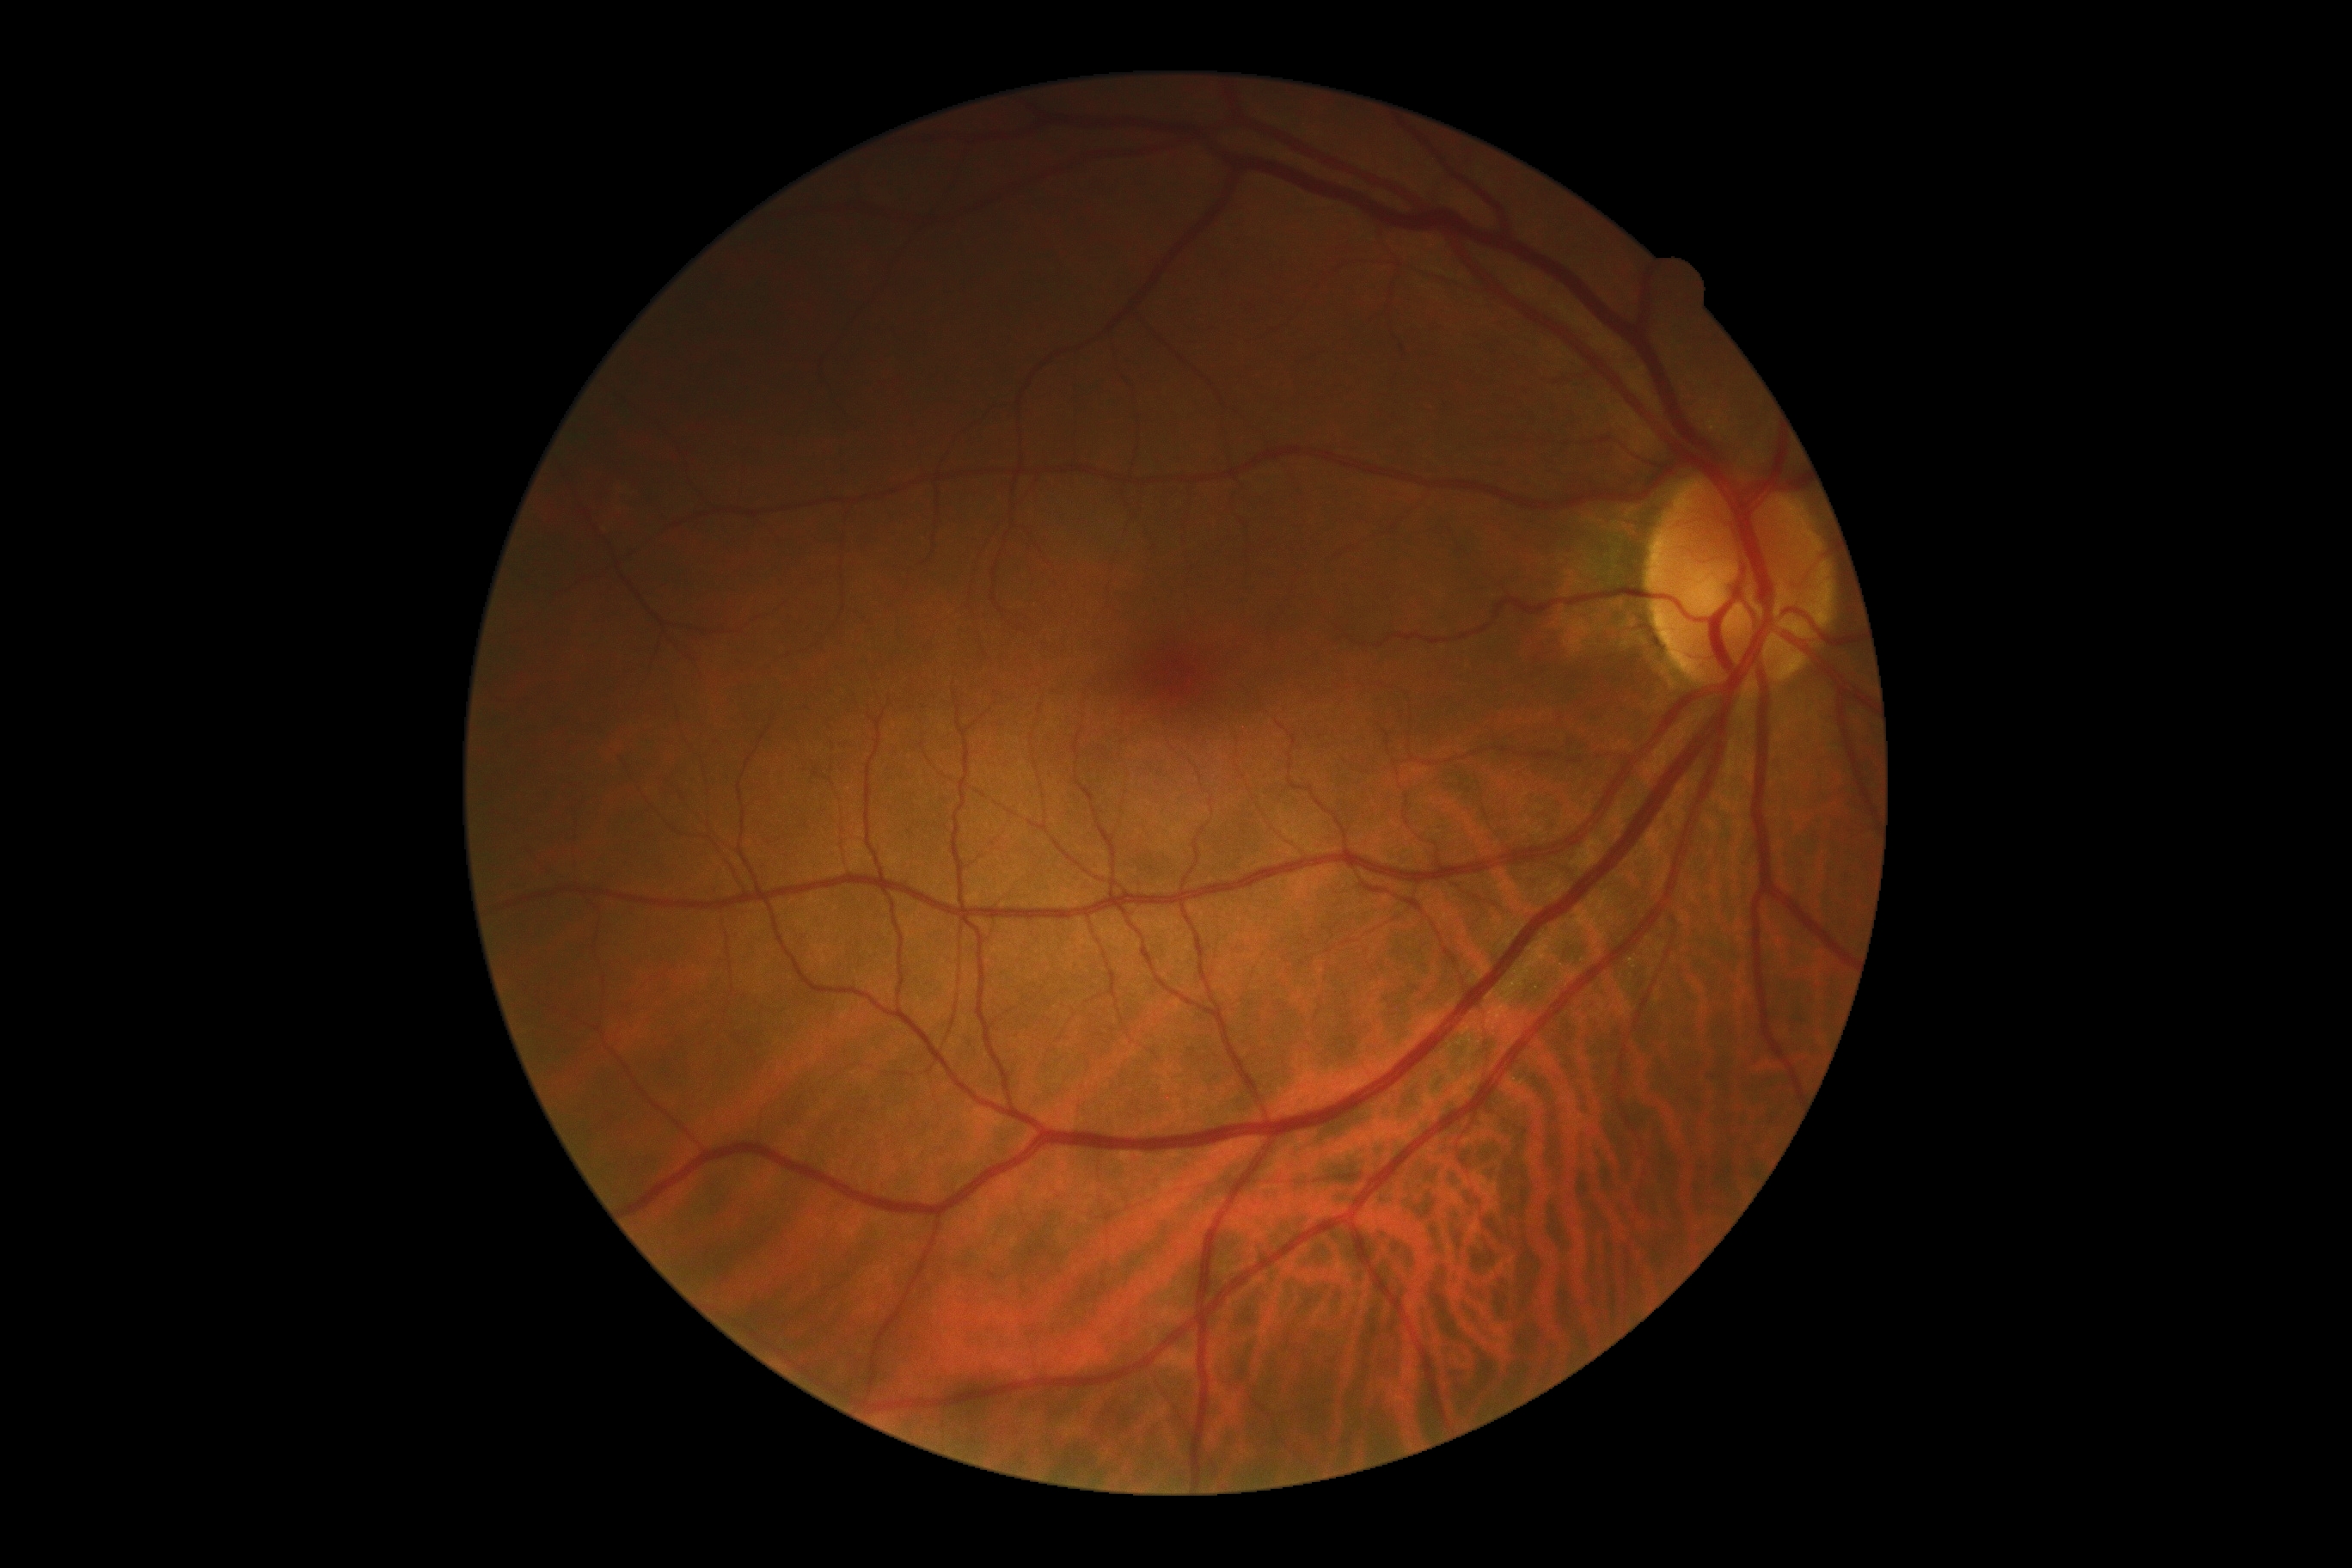 DR impression: no DR findings; diabetic retinopathy (DR): 0/4.